Color fundus photograph. Image size 1659x2212. Remidio Fundus on Phone (FOP) camera:
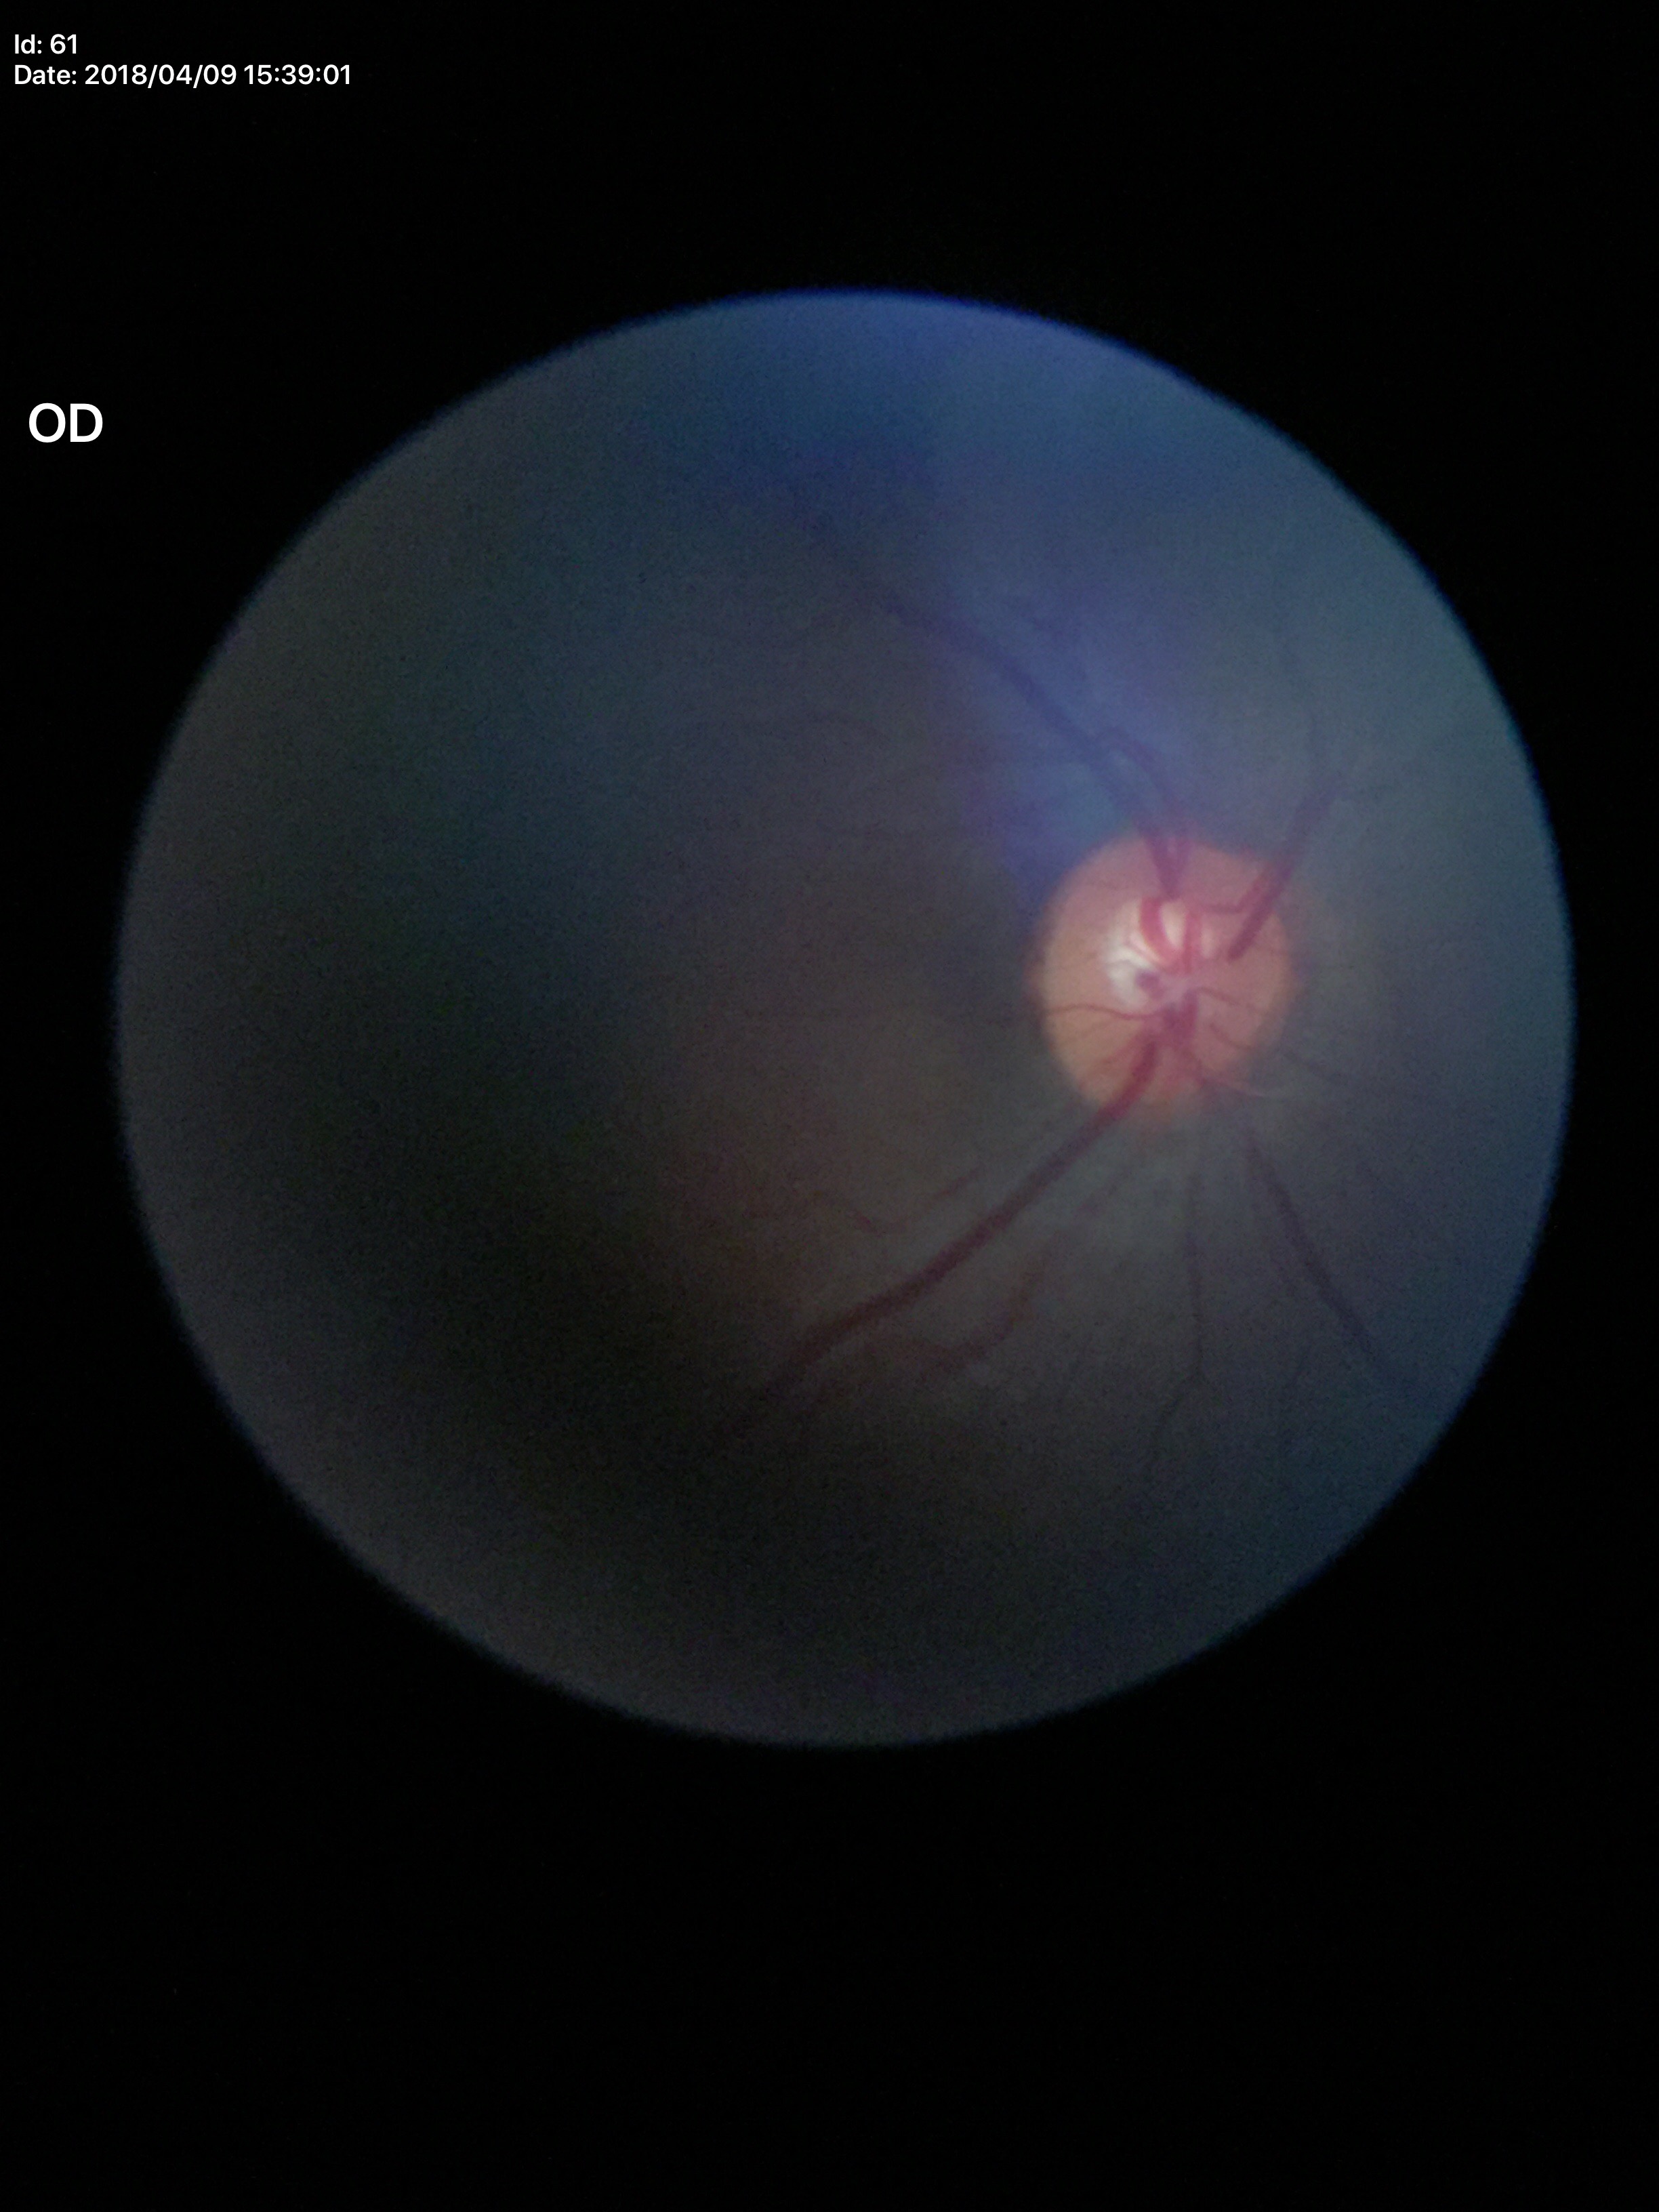

No glaucomatous findings. Vertical C/D ratio (VCDR): 0.52.